Camera: Phoenix ICON (100° FOV) · Phoenix ICON wide-field infant fundus image:
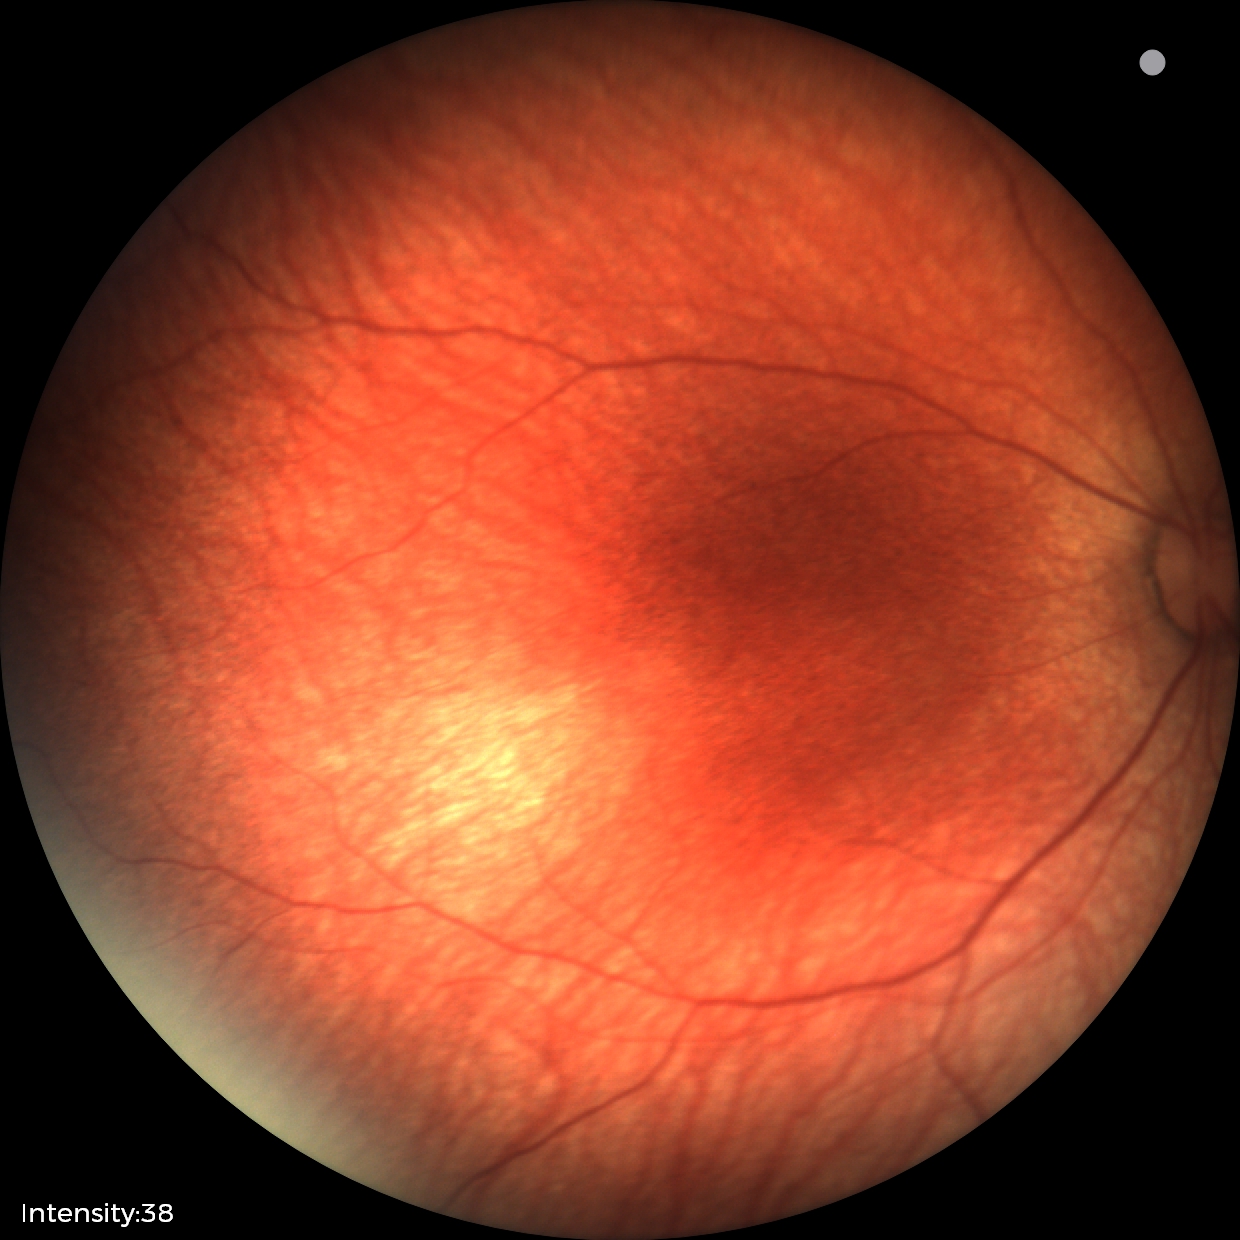

Screening examination diagnosed as physiological.